Wide-field fundus photograph of an infant; 640 x 480 pixels; Clarity RetCam 3, 130° FOV: 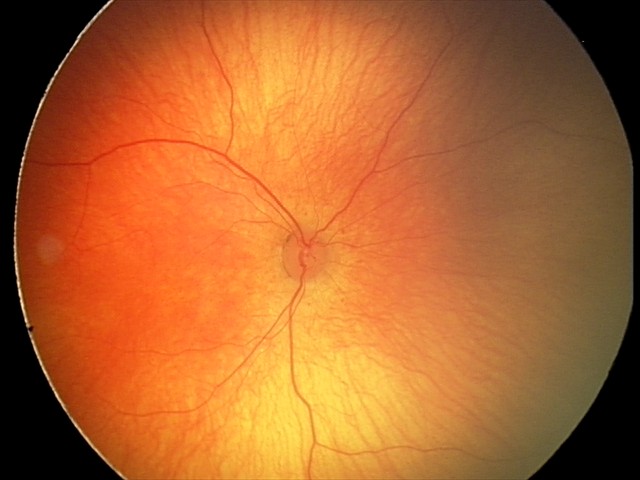
Assessment: physiological appearance with no retinal pathology.